45-degree field of view · 1932 x 1932 pixels: 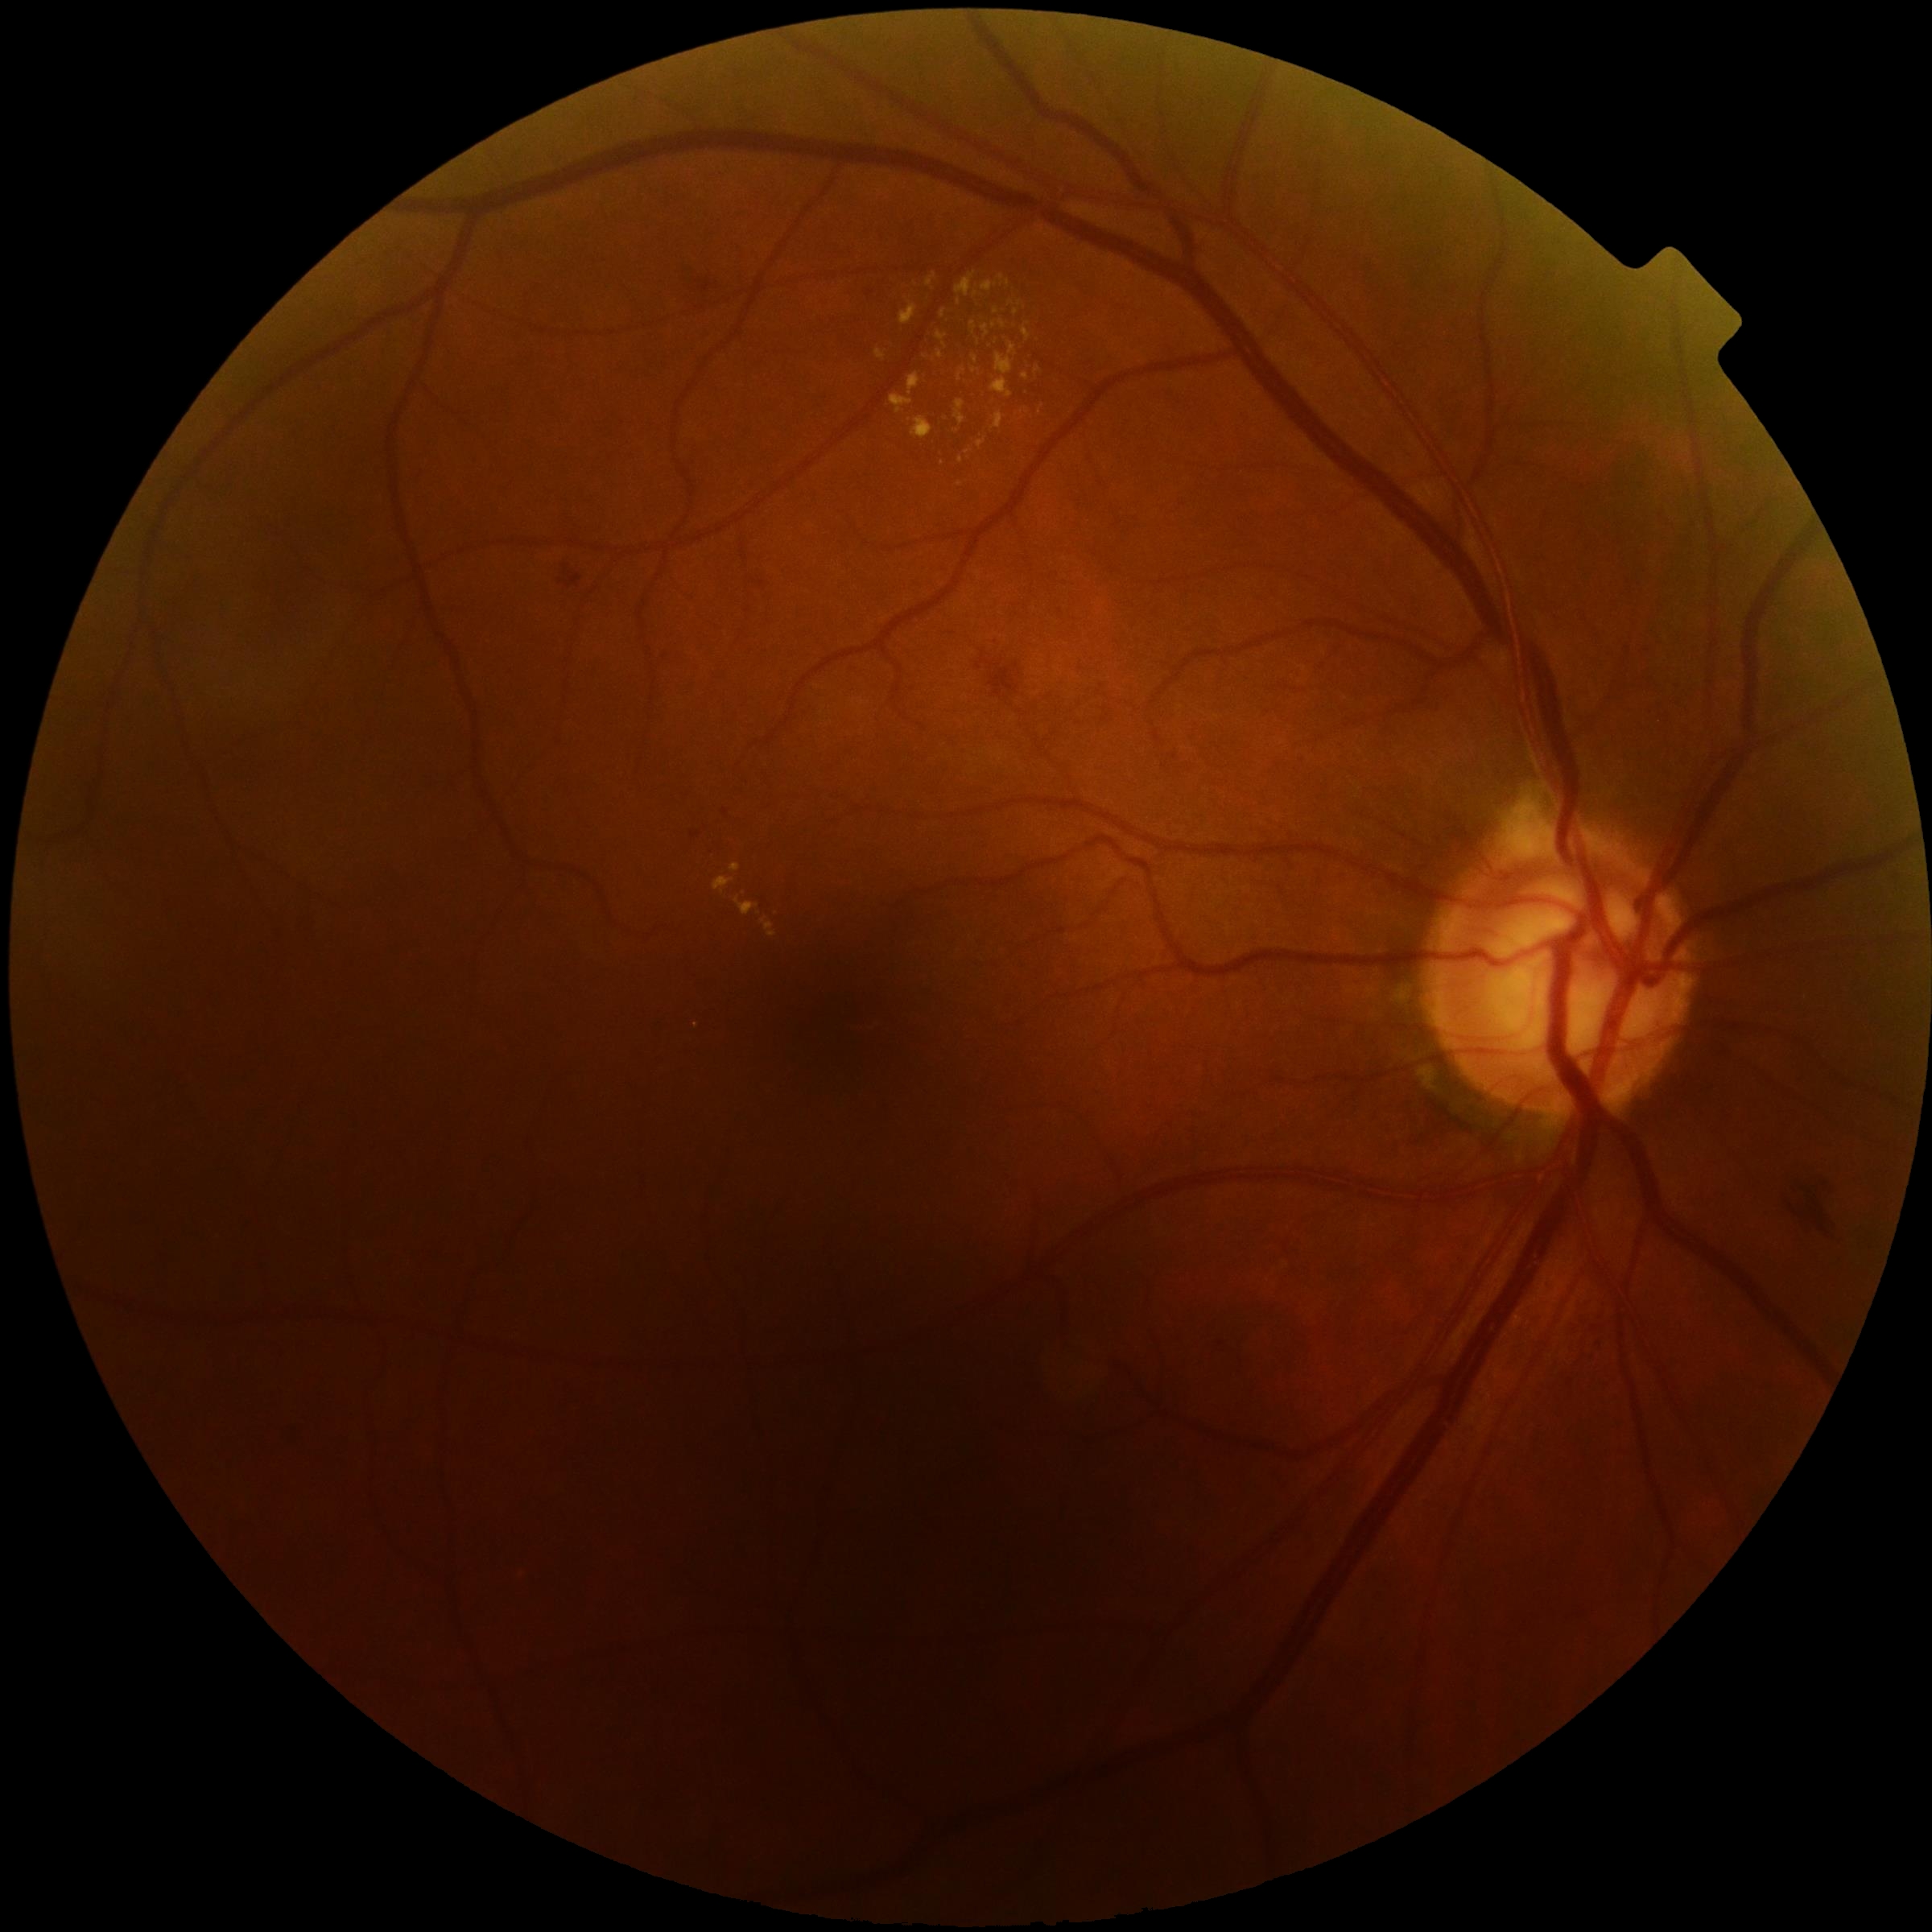 The retinopathy is classified as non-proliferative diabetic retinopathy.
Diabetic retinopathy severity: grade 2.